Image size 848x848. NIDEK AFC-230. Fundus photo
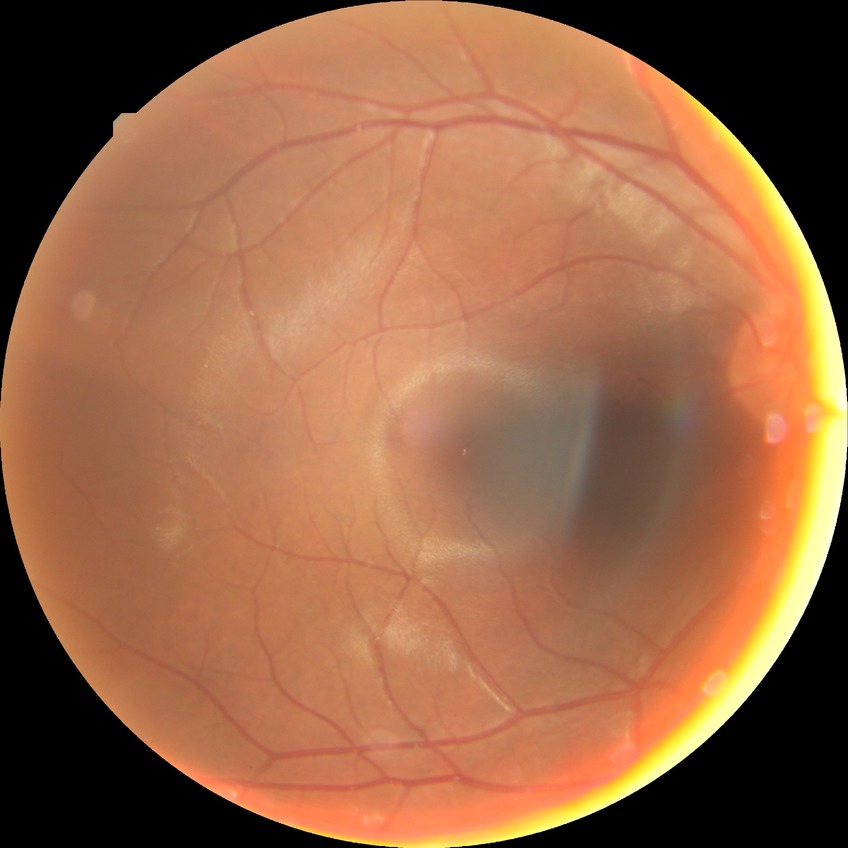

Diabetic retinopathy (DR) is NDR (no diabetic retinopathy).